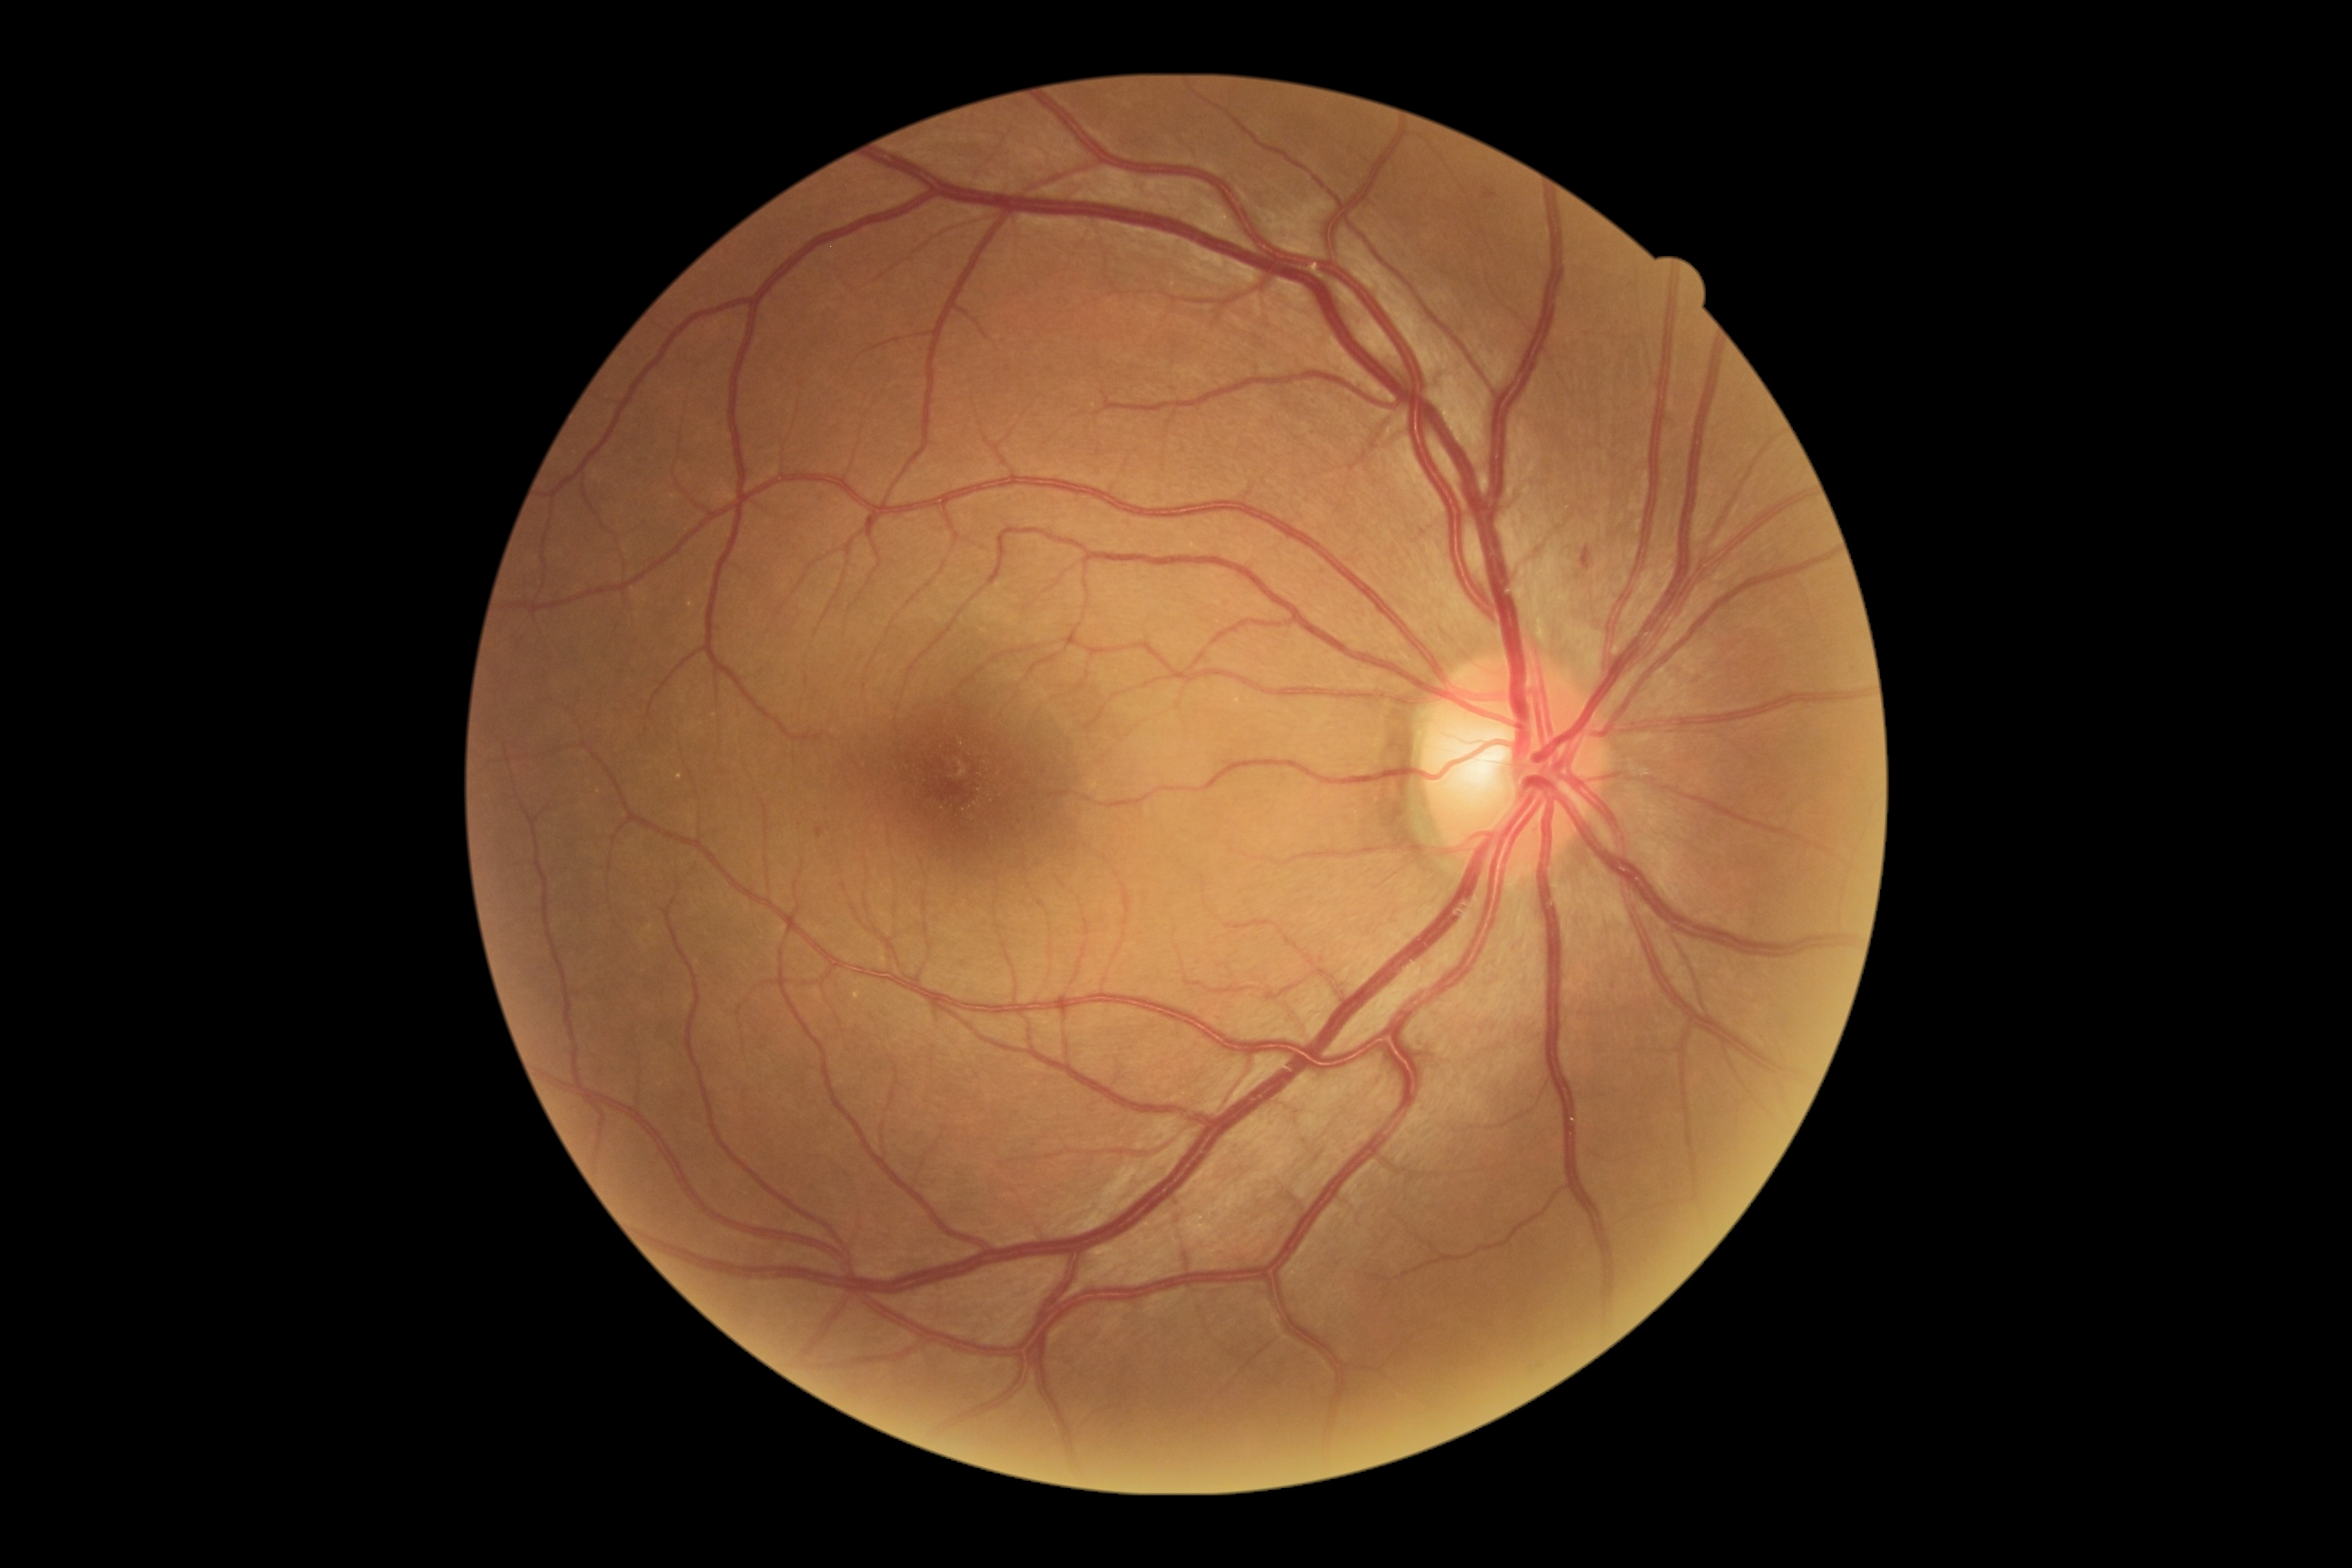

DR class: non-proliferative diabetic retinopathy. Diabetic retinopathy (DR) is mild NPDR (grade 1).